Fundus photo.
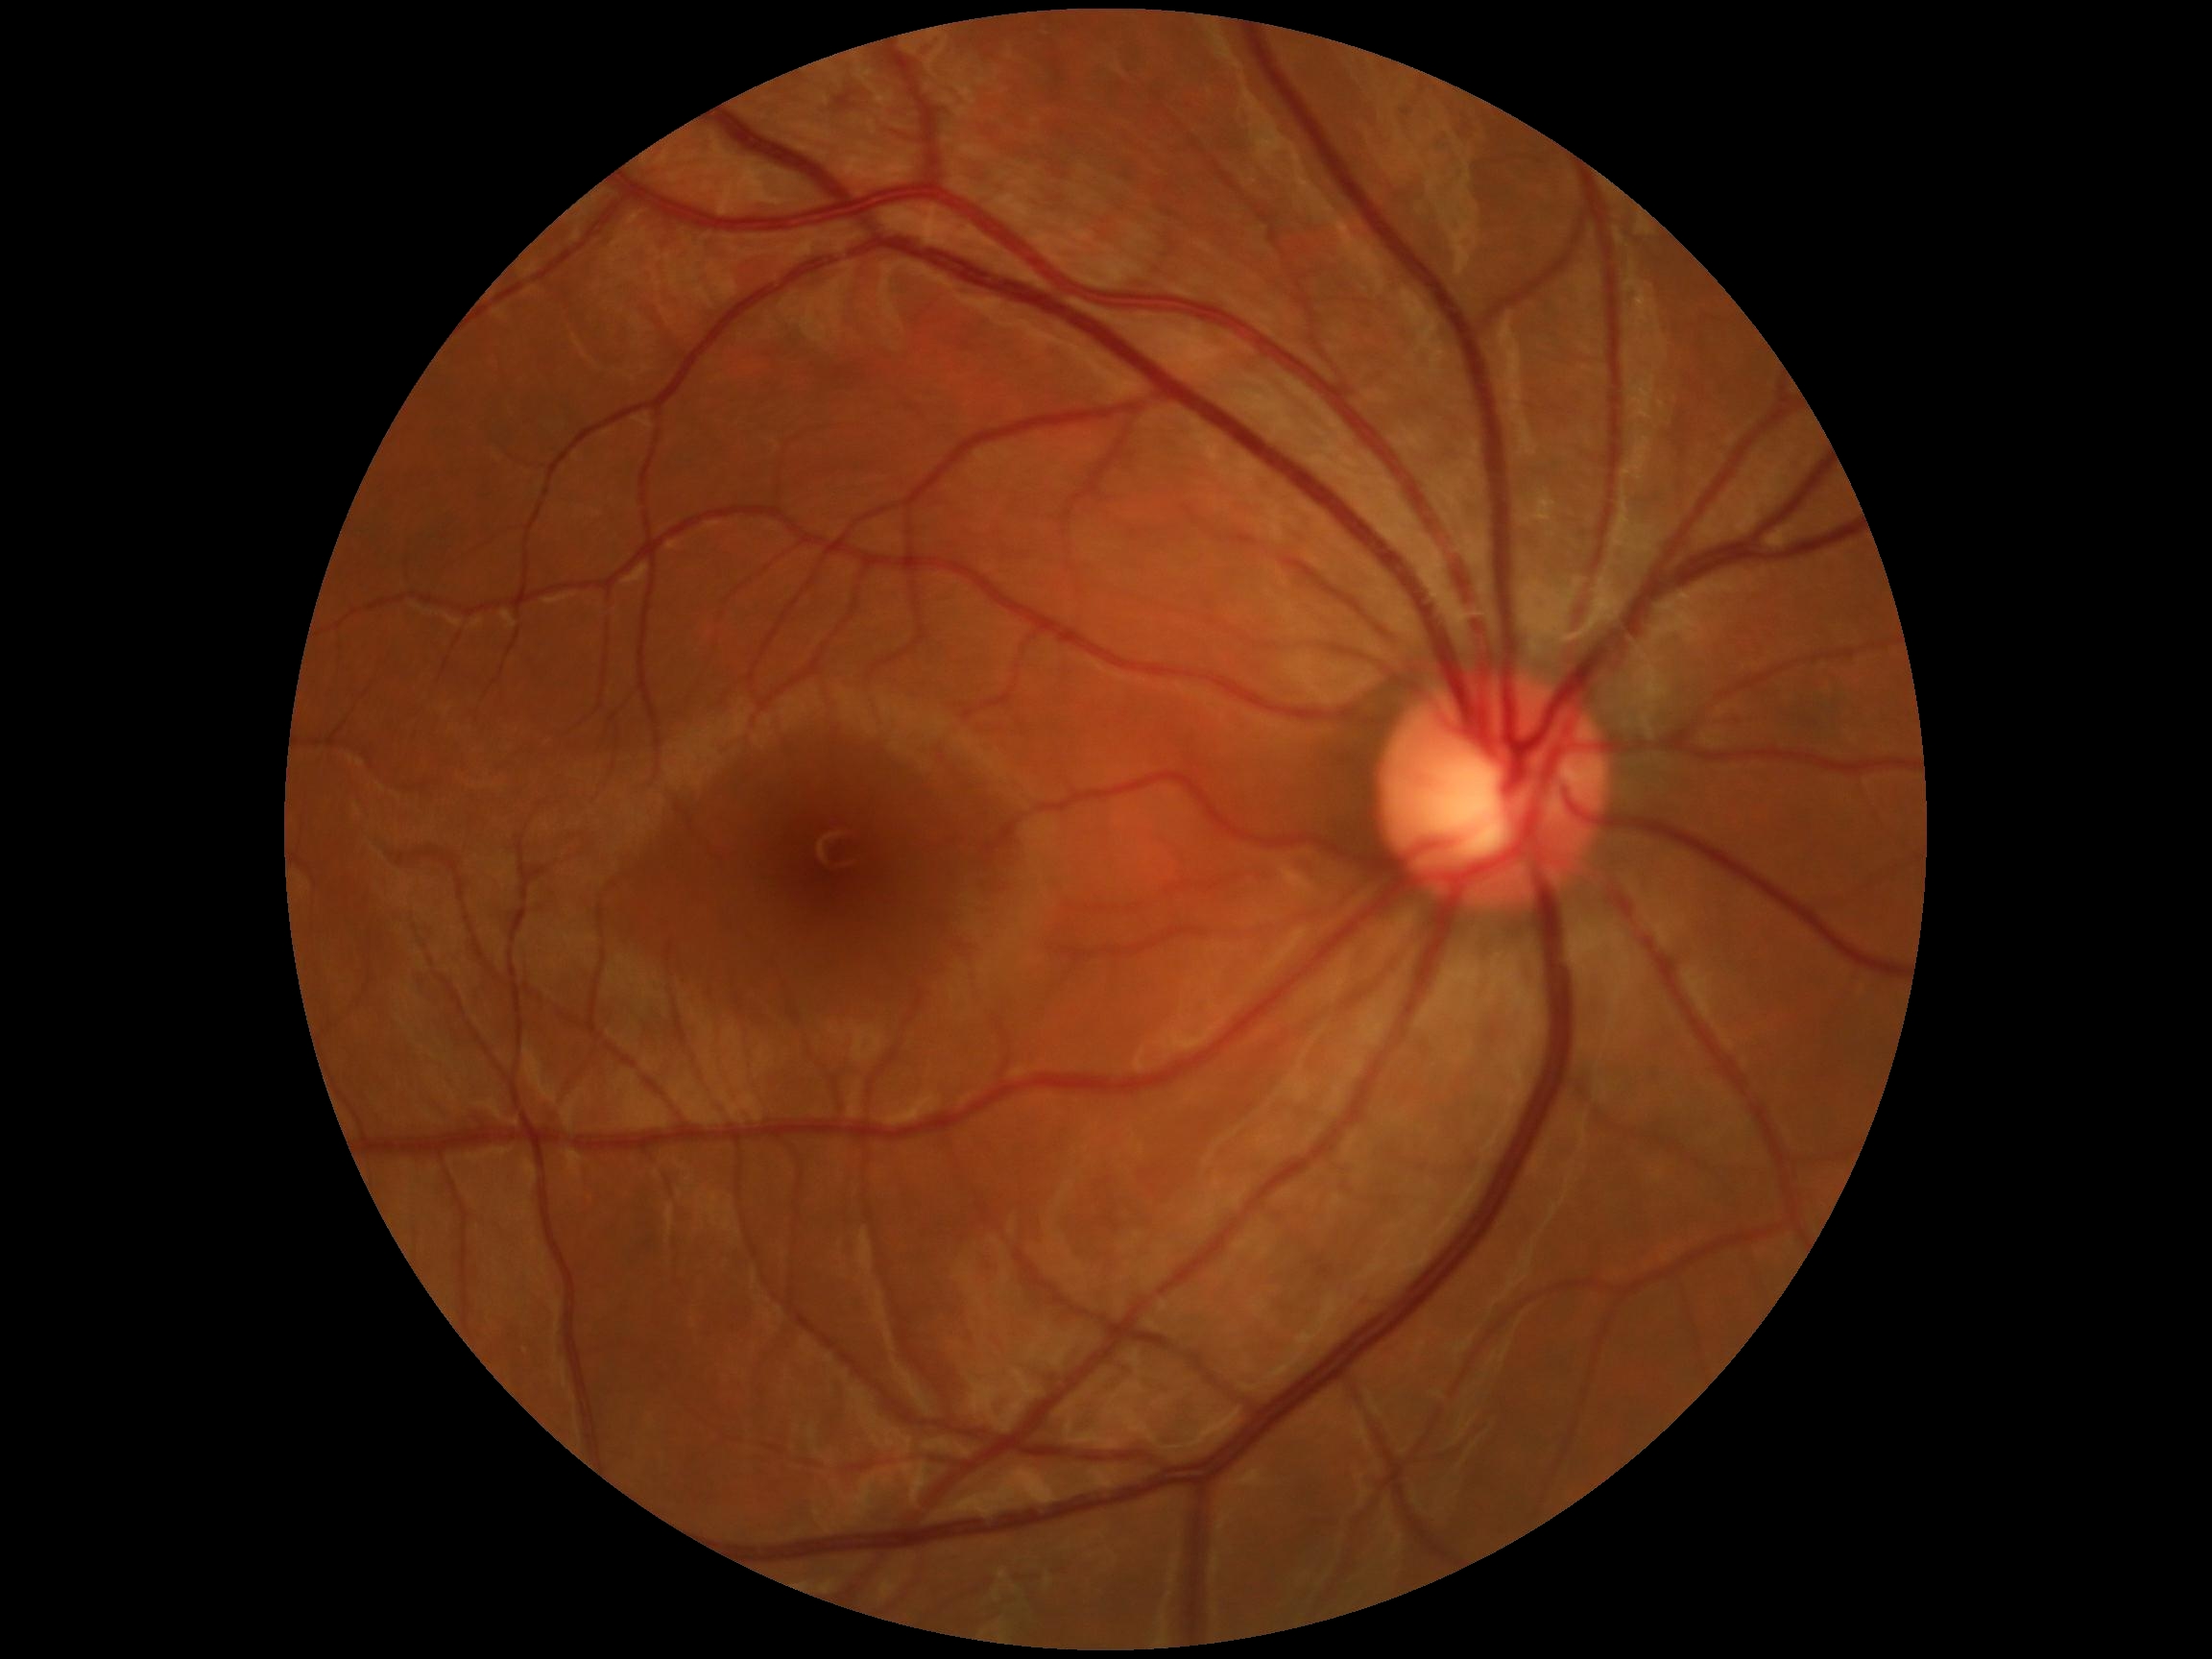

- DR grade: no apparent retinopathy (0)